Acquired with a Nidek AFC-330
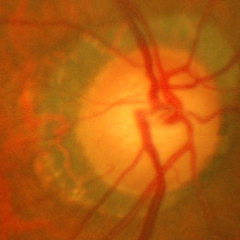 Findings consistent with early glaucoma.